640 x 480 pixels · infant wide-field retinal image
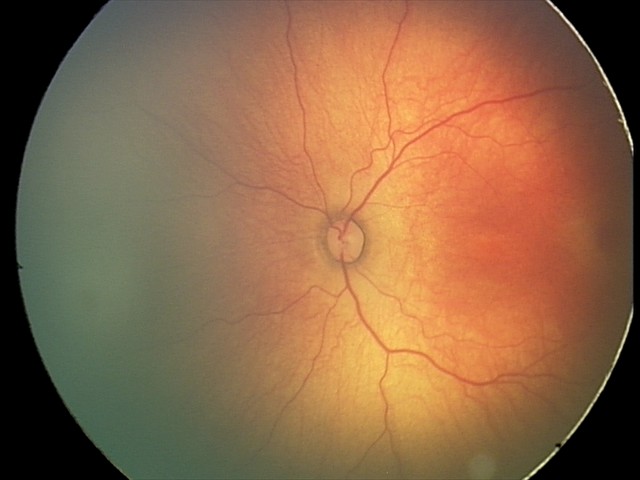
Screening examination consistent with status post ROP.